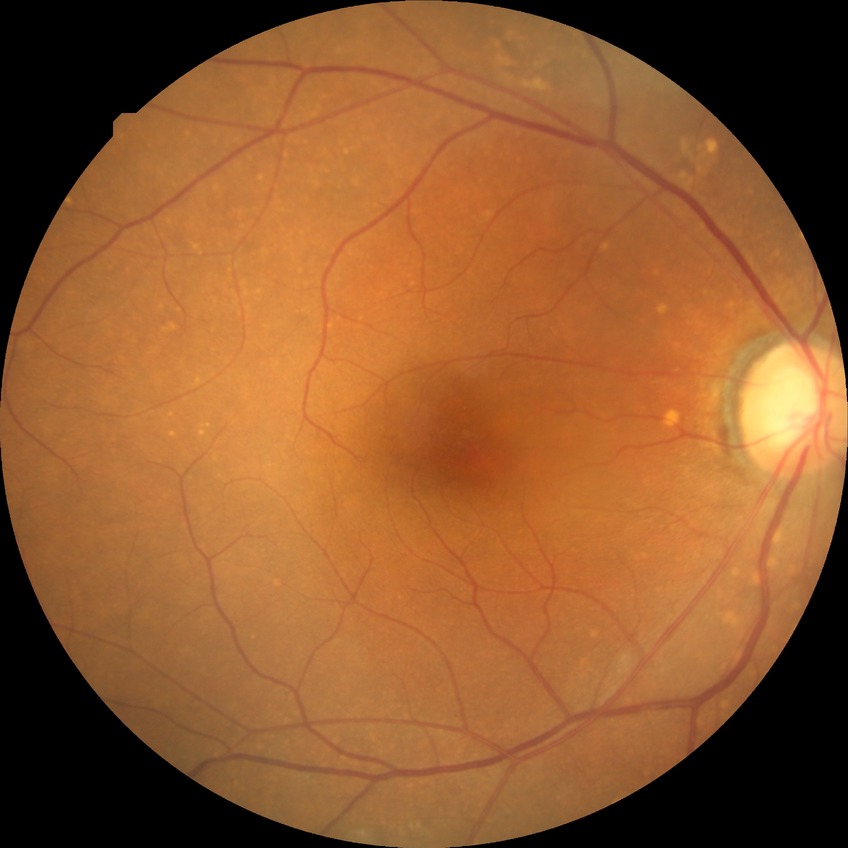   davis_grade: no diabetic retinopathy (NDR)